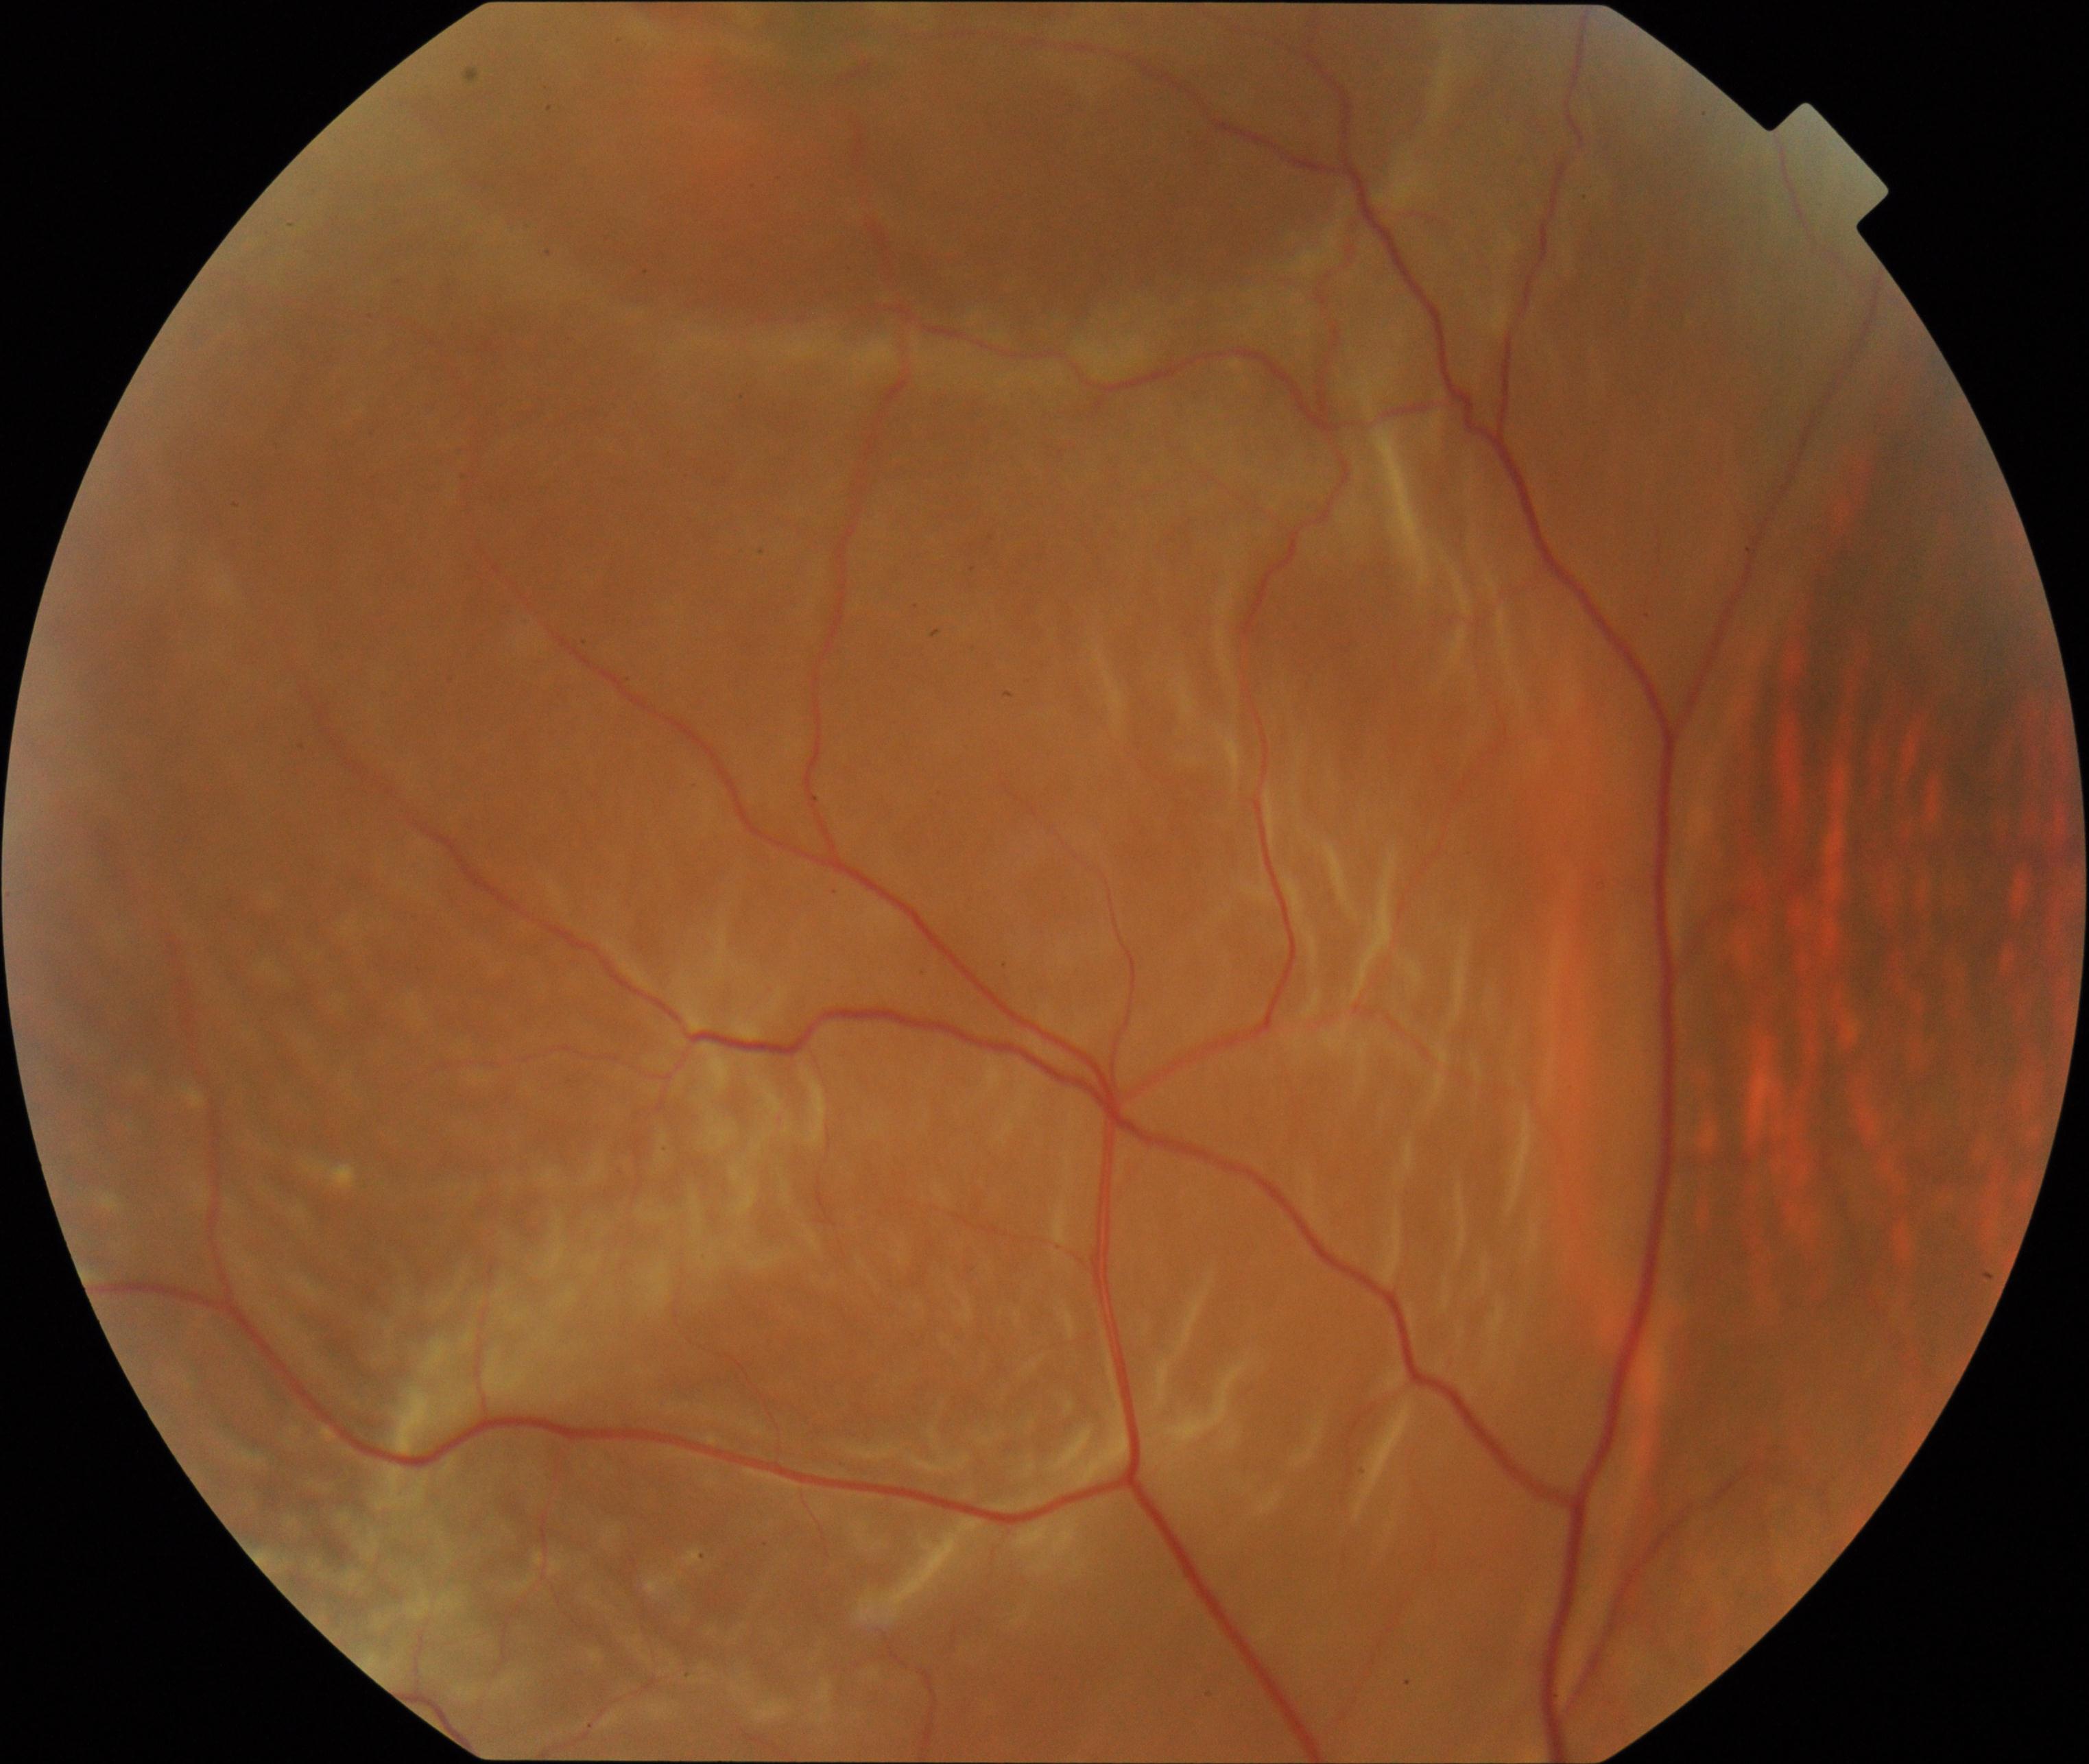 Retinal fundus photograph demonstrating rhegmatogenous retinal detachment.